Modified Davis grading.
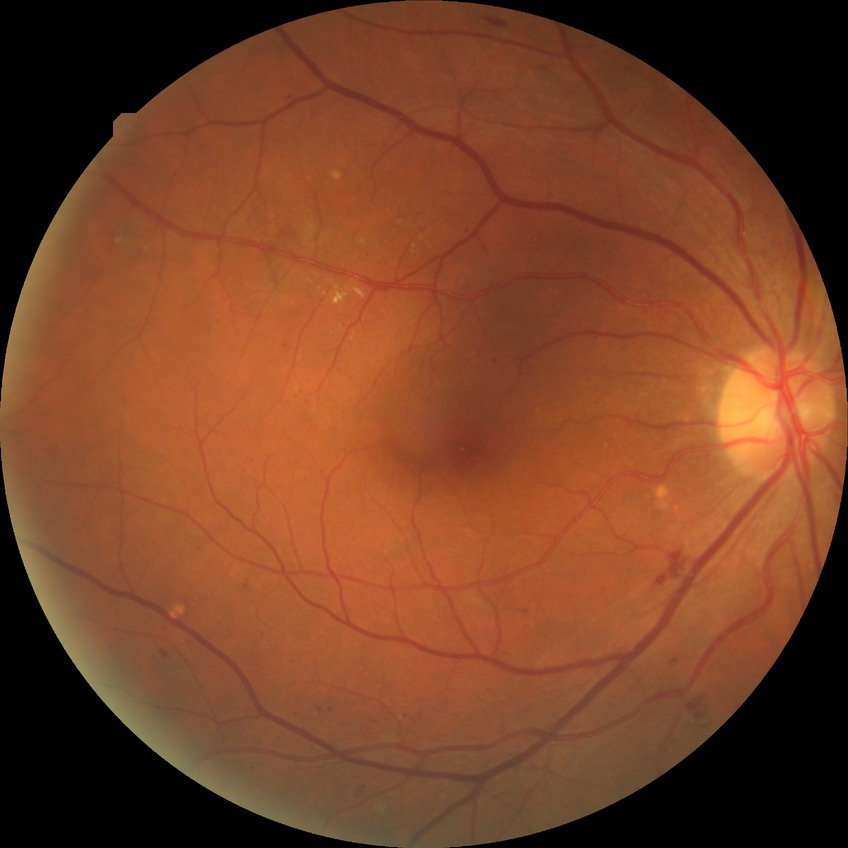
retinopathy grade@pre-proliferative diabetic retinopathy.